CFP
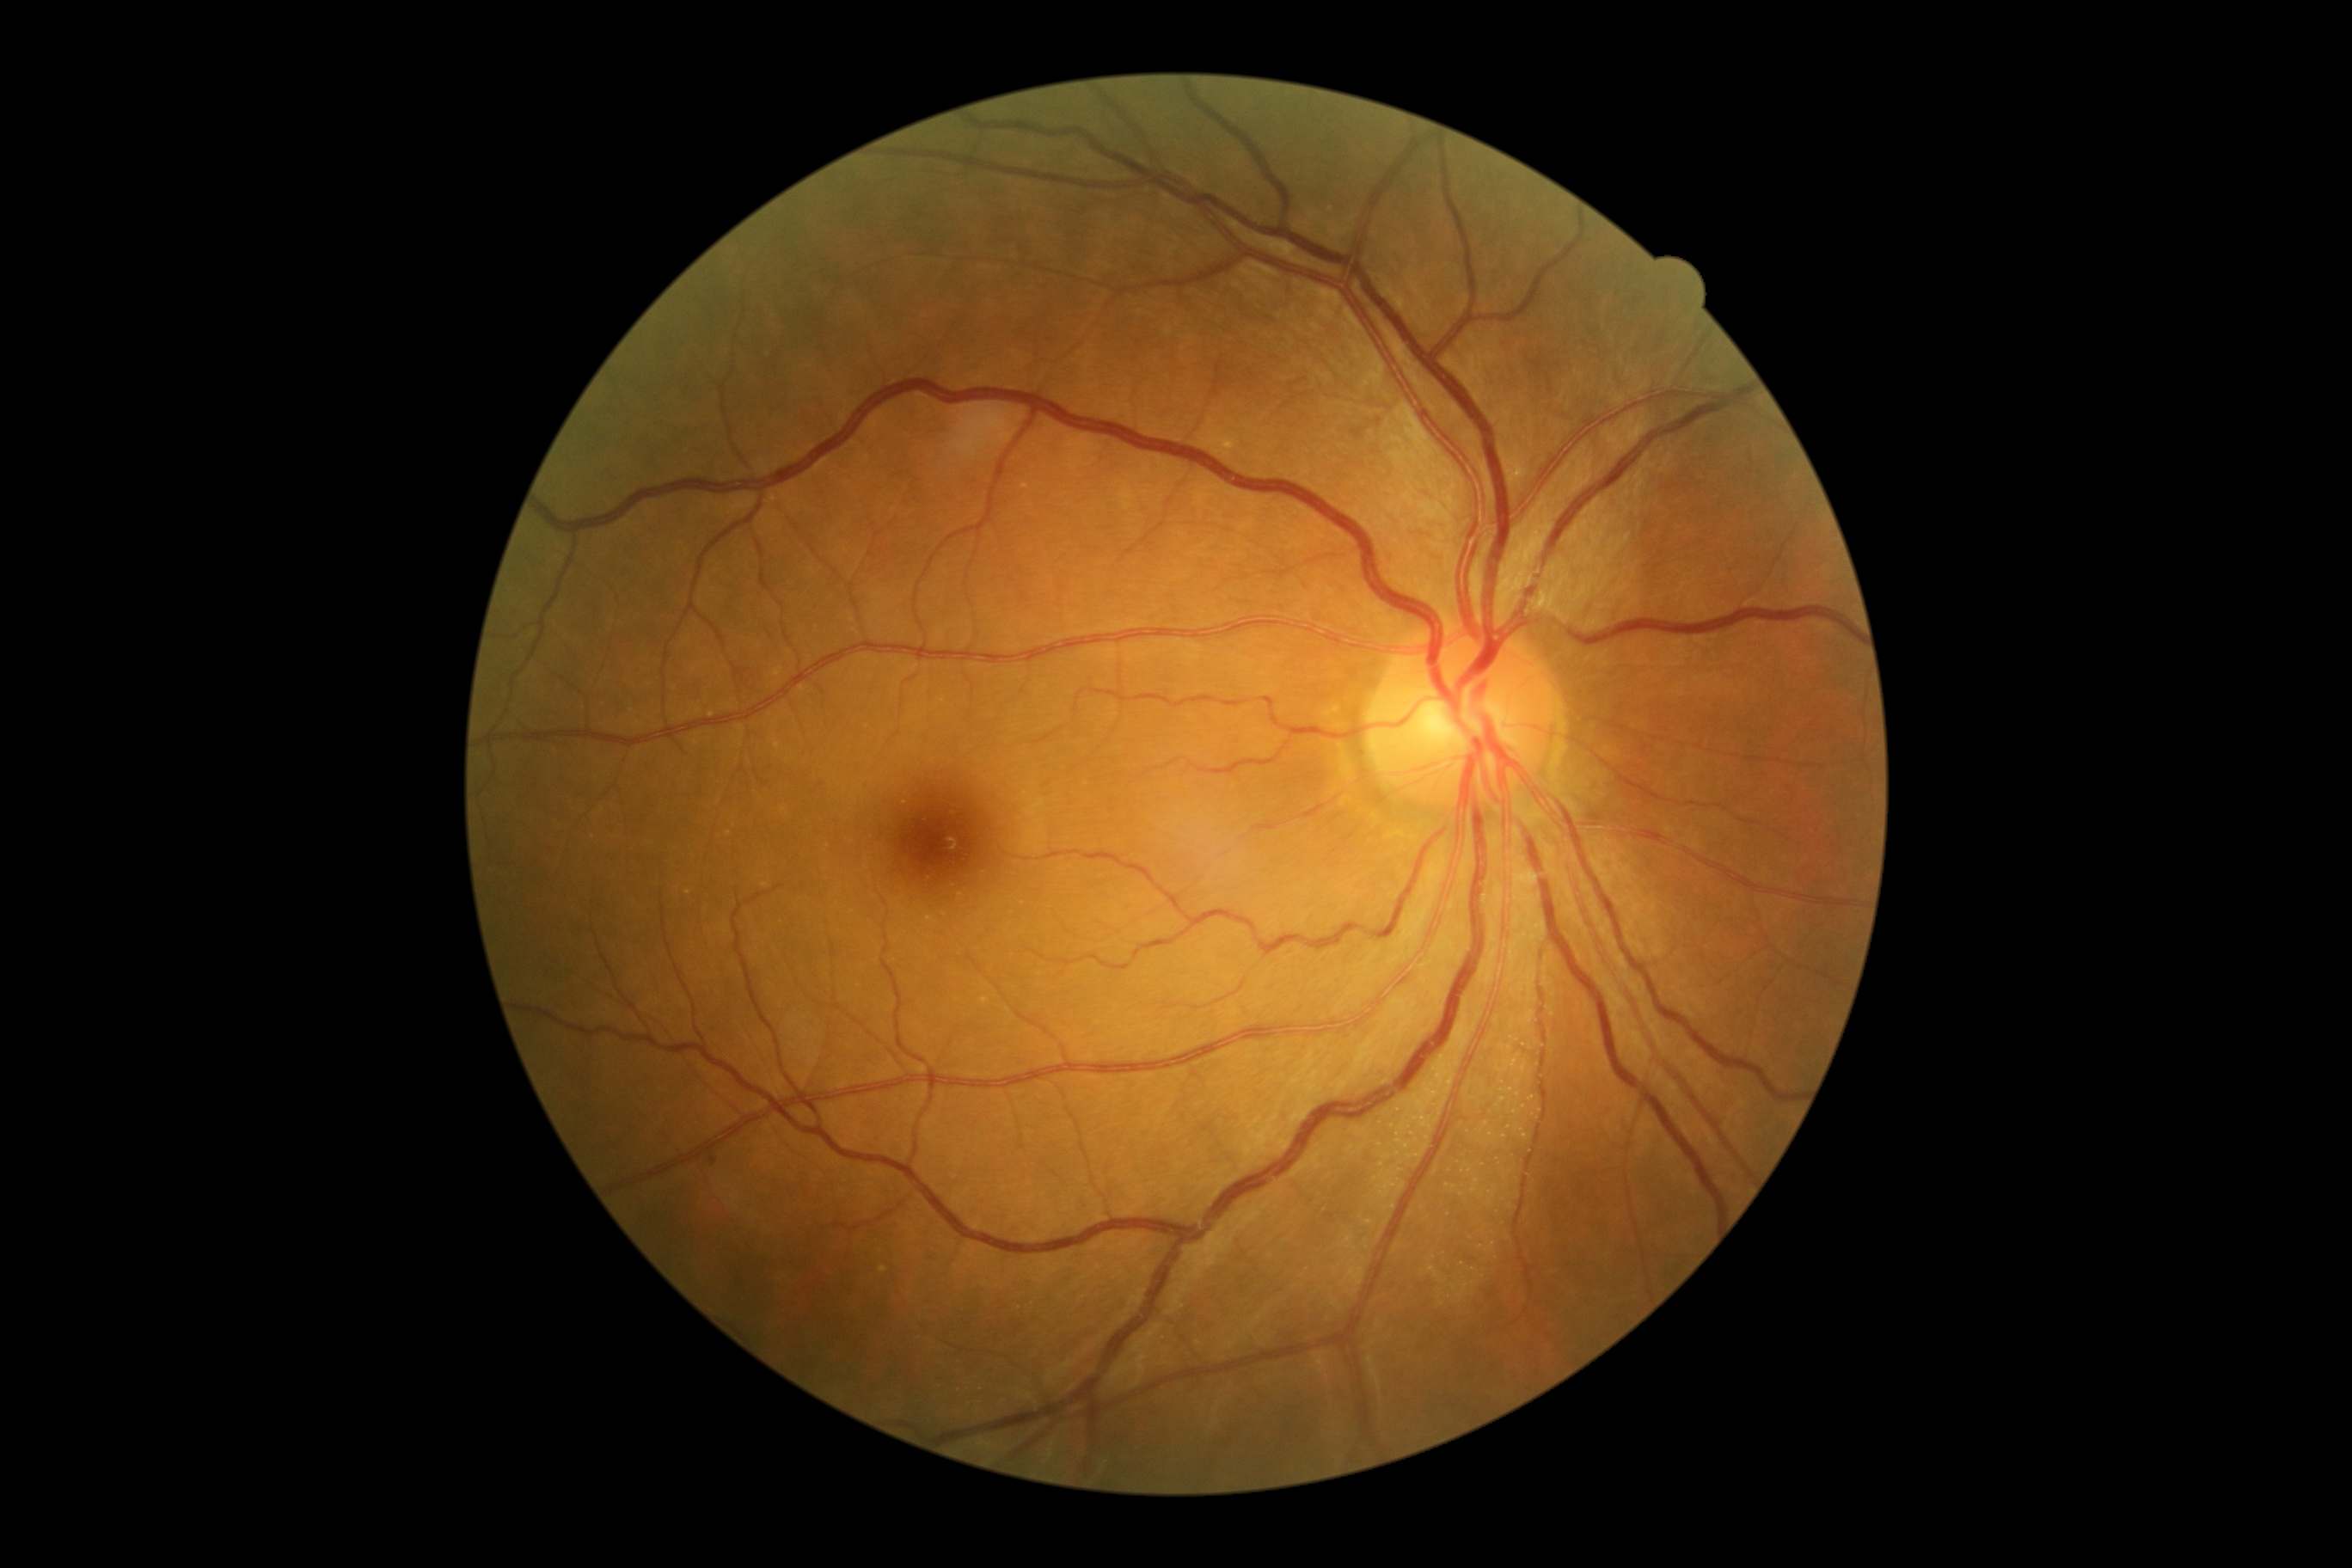

The retinopathy is classified as non-proliferative diabetic retinopathy. DR is grade 1 (mild NPDR).